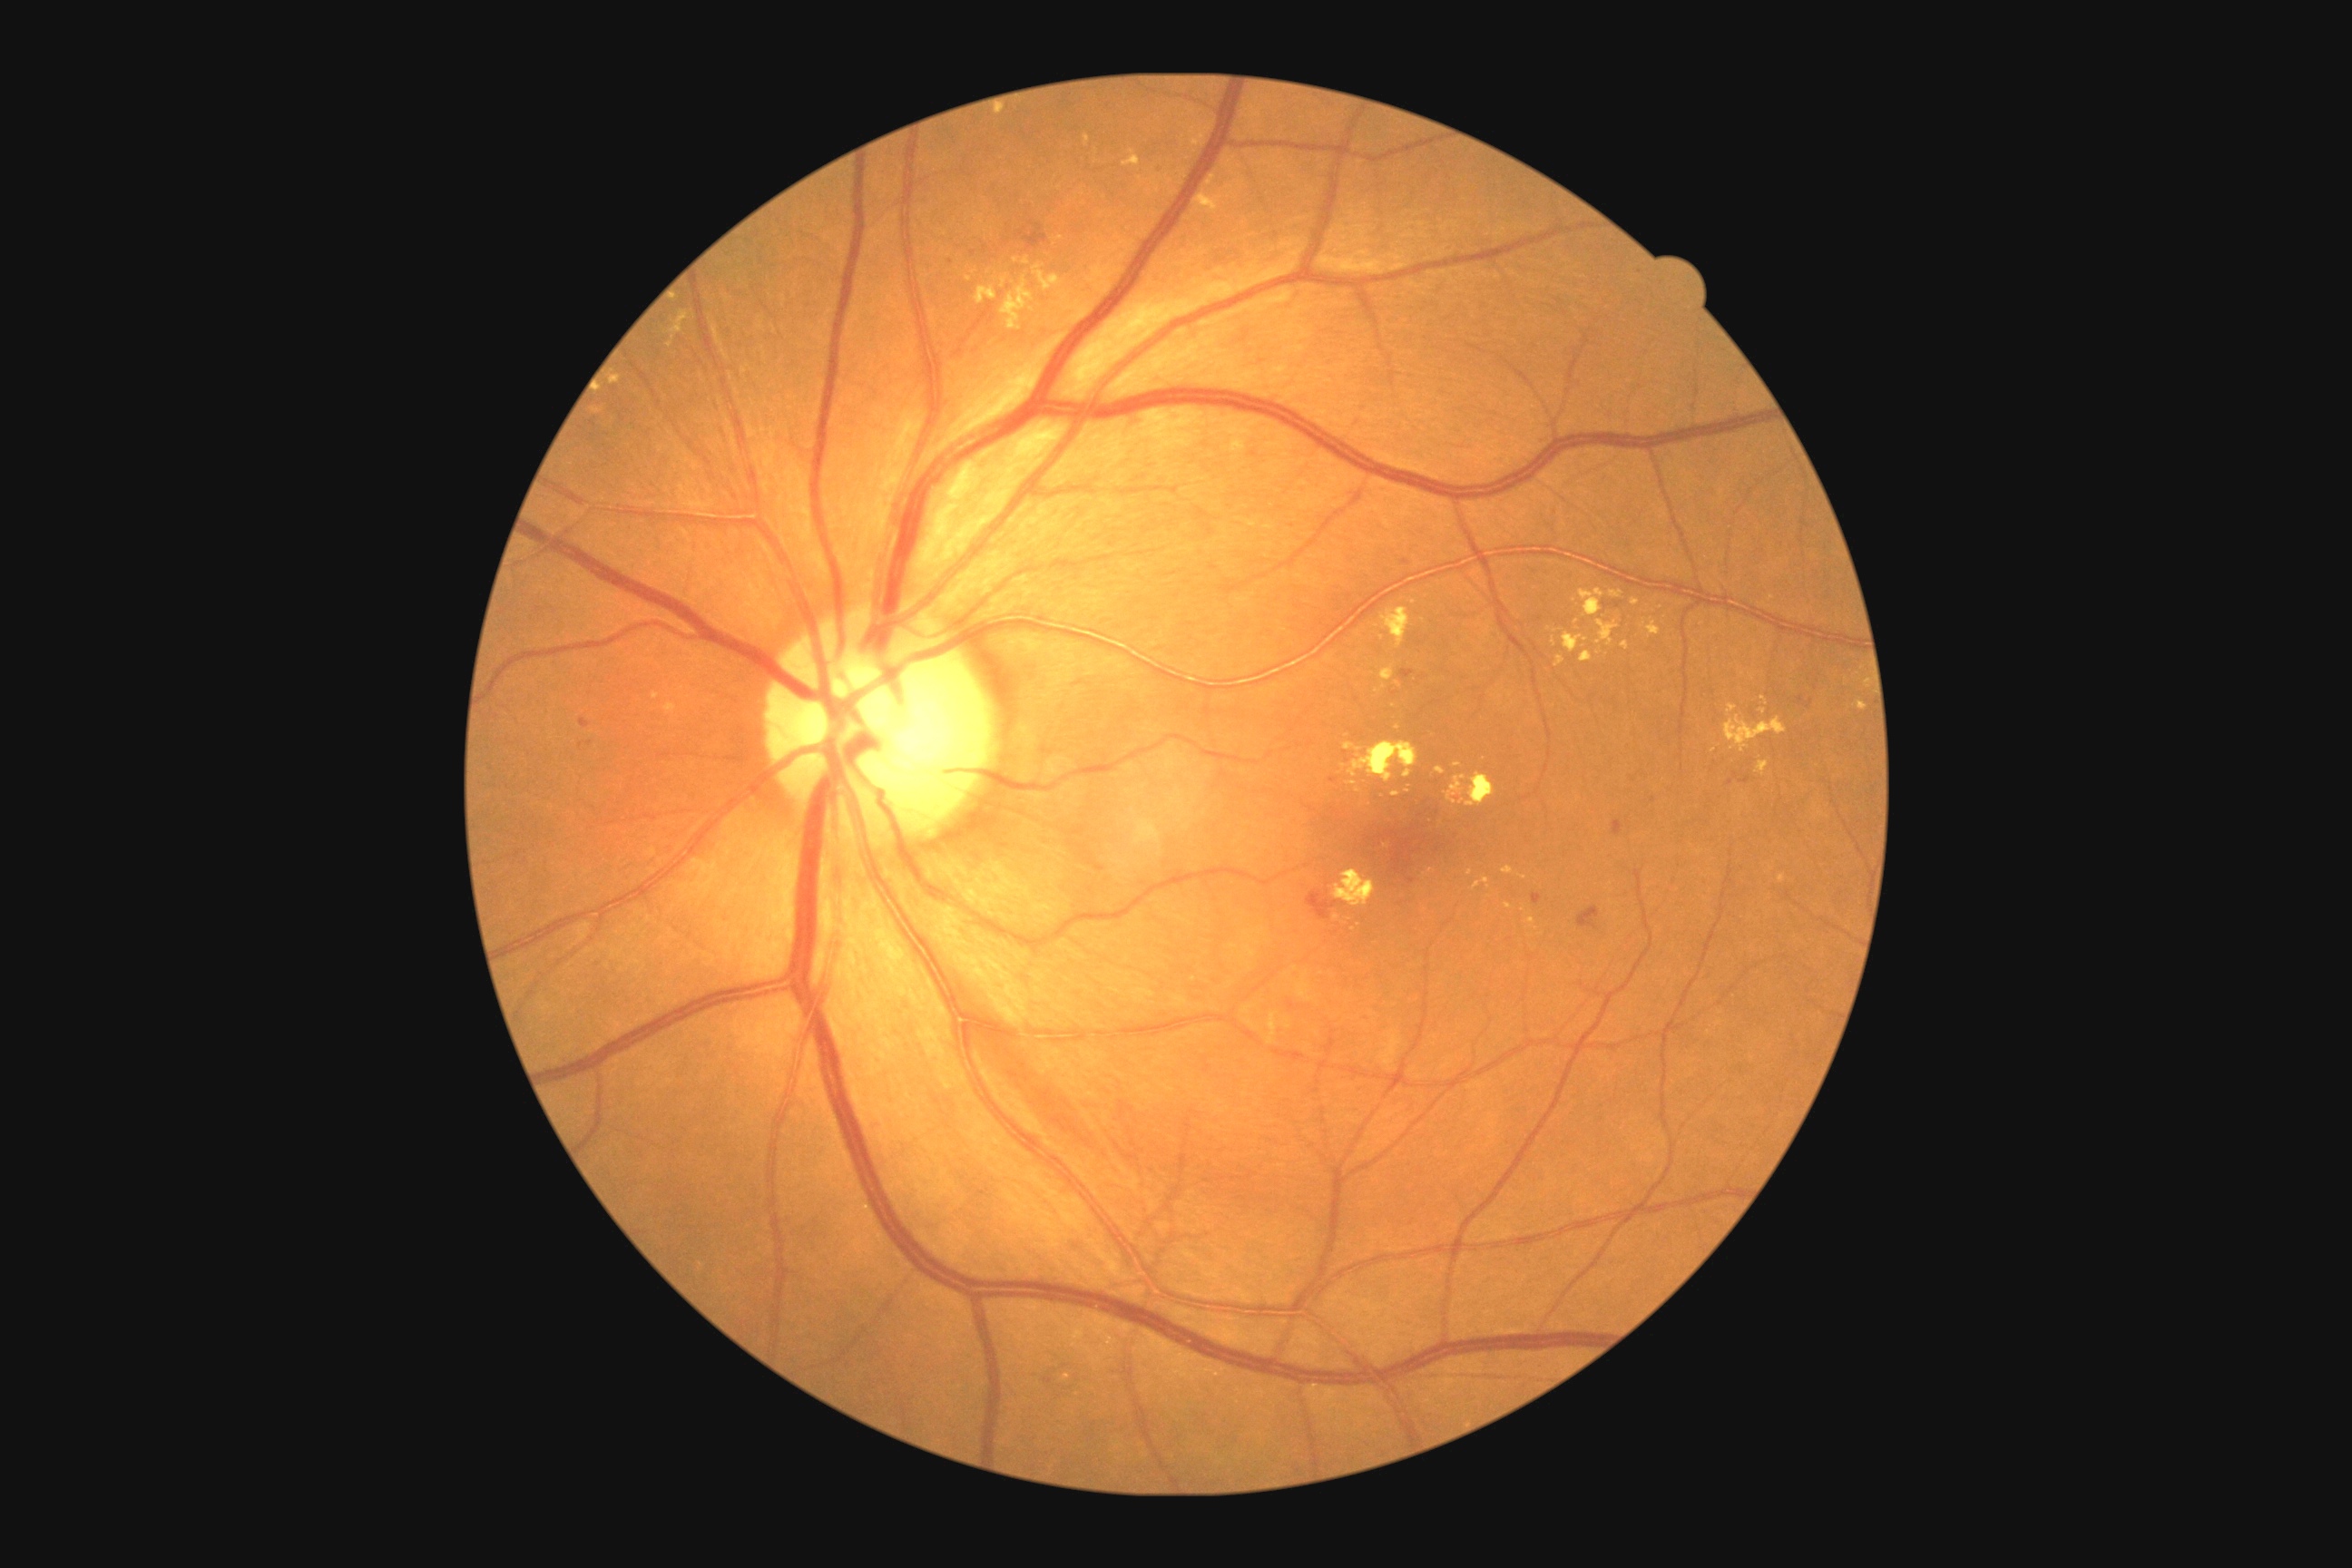
partial: true
dr_grade: 2
dr_grade_name: moderate NPDR
lesions:
  ex:
    - 1391 792 1400 798
    - 1206 175 1217 186
    - 1190 119 1217 148
    - 1460 772 1496 807
    - 1527 917 1534 926
    - 1622 642 1631 651
    - 1348 783 1357 787
    - 1001 277 1008 289
    - 1756 761 1769 776
    - 1759 710 1767 714
    - 1084 135 1092 146
    - 1349 741 1418 783
    - 1124 150 1141 166
    - 1596 622 1620 647
  ex_small_centers:
    - (x=1561, y=630)
    - (x=1390, y=592)
    - (x=1382, y=638)
    - (x=1866, y=685)
    - (x=1399, y=684)
  ma: []
  se: []
  he:
    - 1578 906 1602 932
    - 1329 778 1338 783
    - 1402 669 1415 680
    - 1740 778 1750 783
    - 1533 894 1542 905
    - 1308 890 1338 921
  he_small_centers:
    - (x=581, y=745)
    - (x=973, y=254)
    - (x=1653, y=800)
    - (x=1802, y=700)
    - (x=590, y=744)
    - (x=1405, y=562)
    - (x=1605, y=605)
    - (x=1347, y=761)